2212x1661px. Acquired with a Topcon TRC-NW400. Disc-centered field
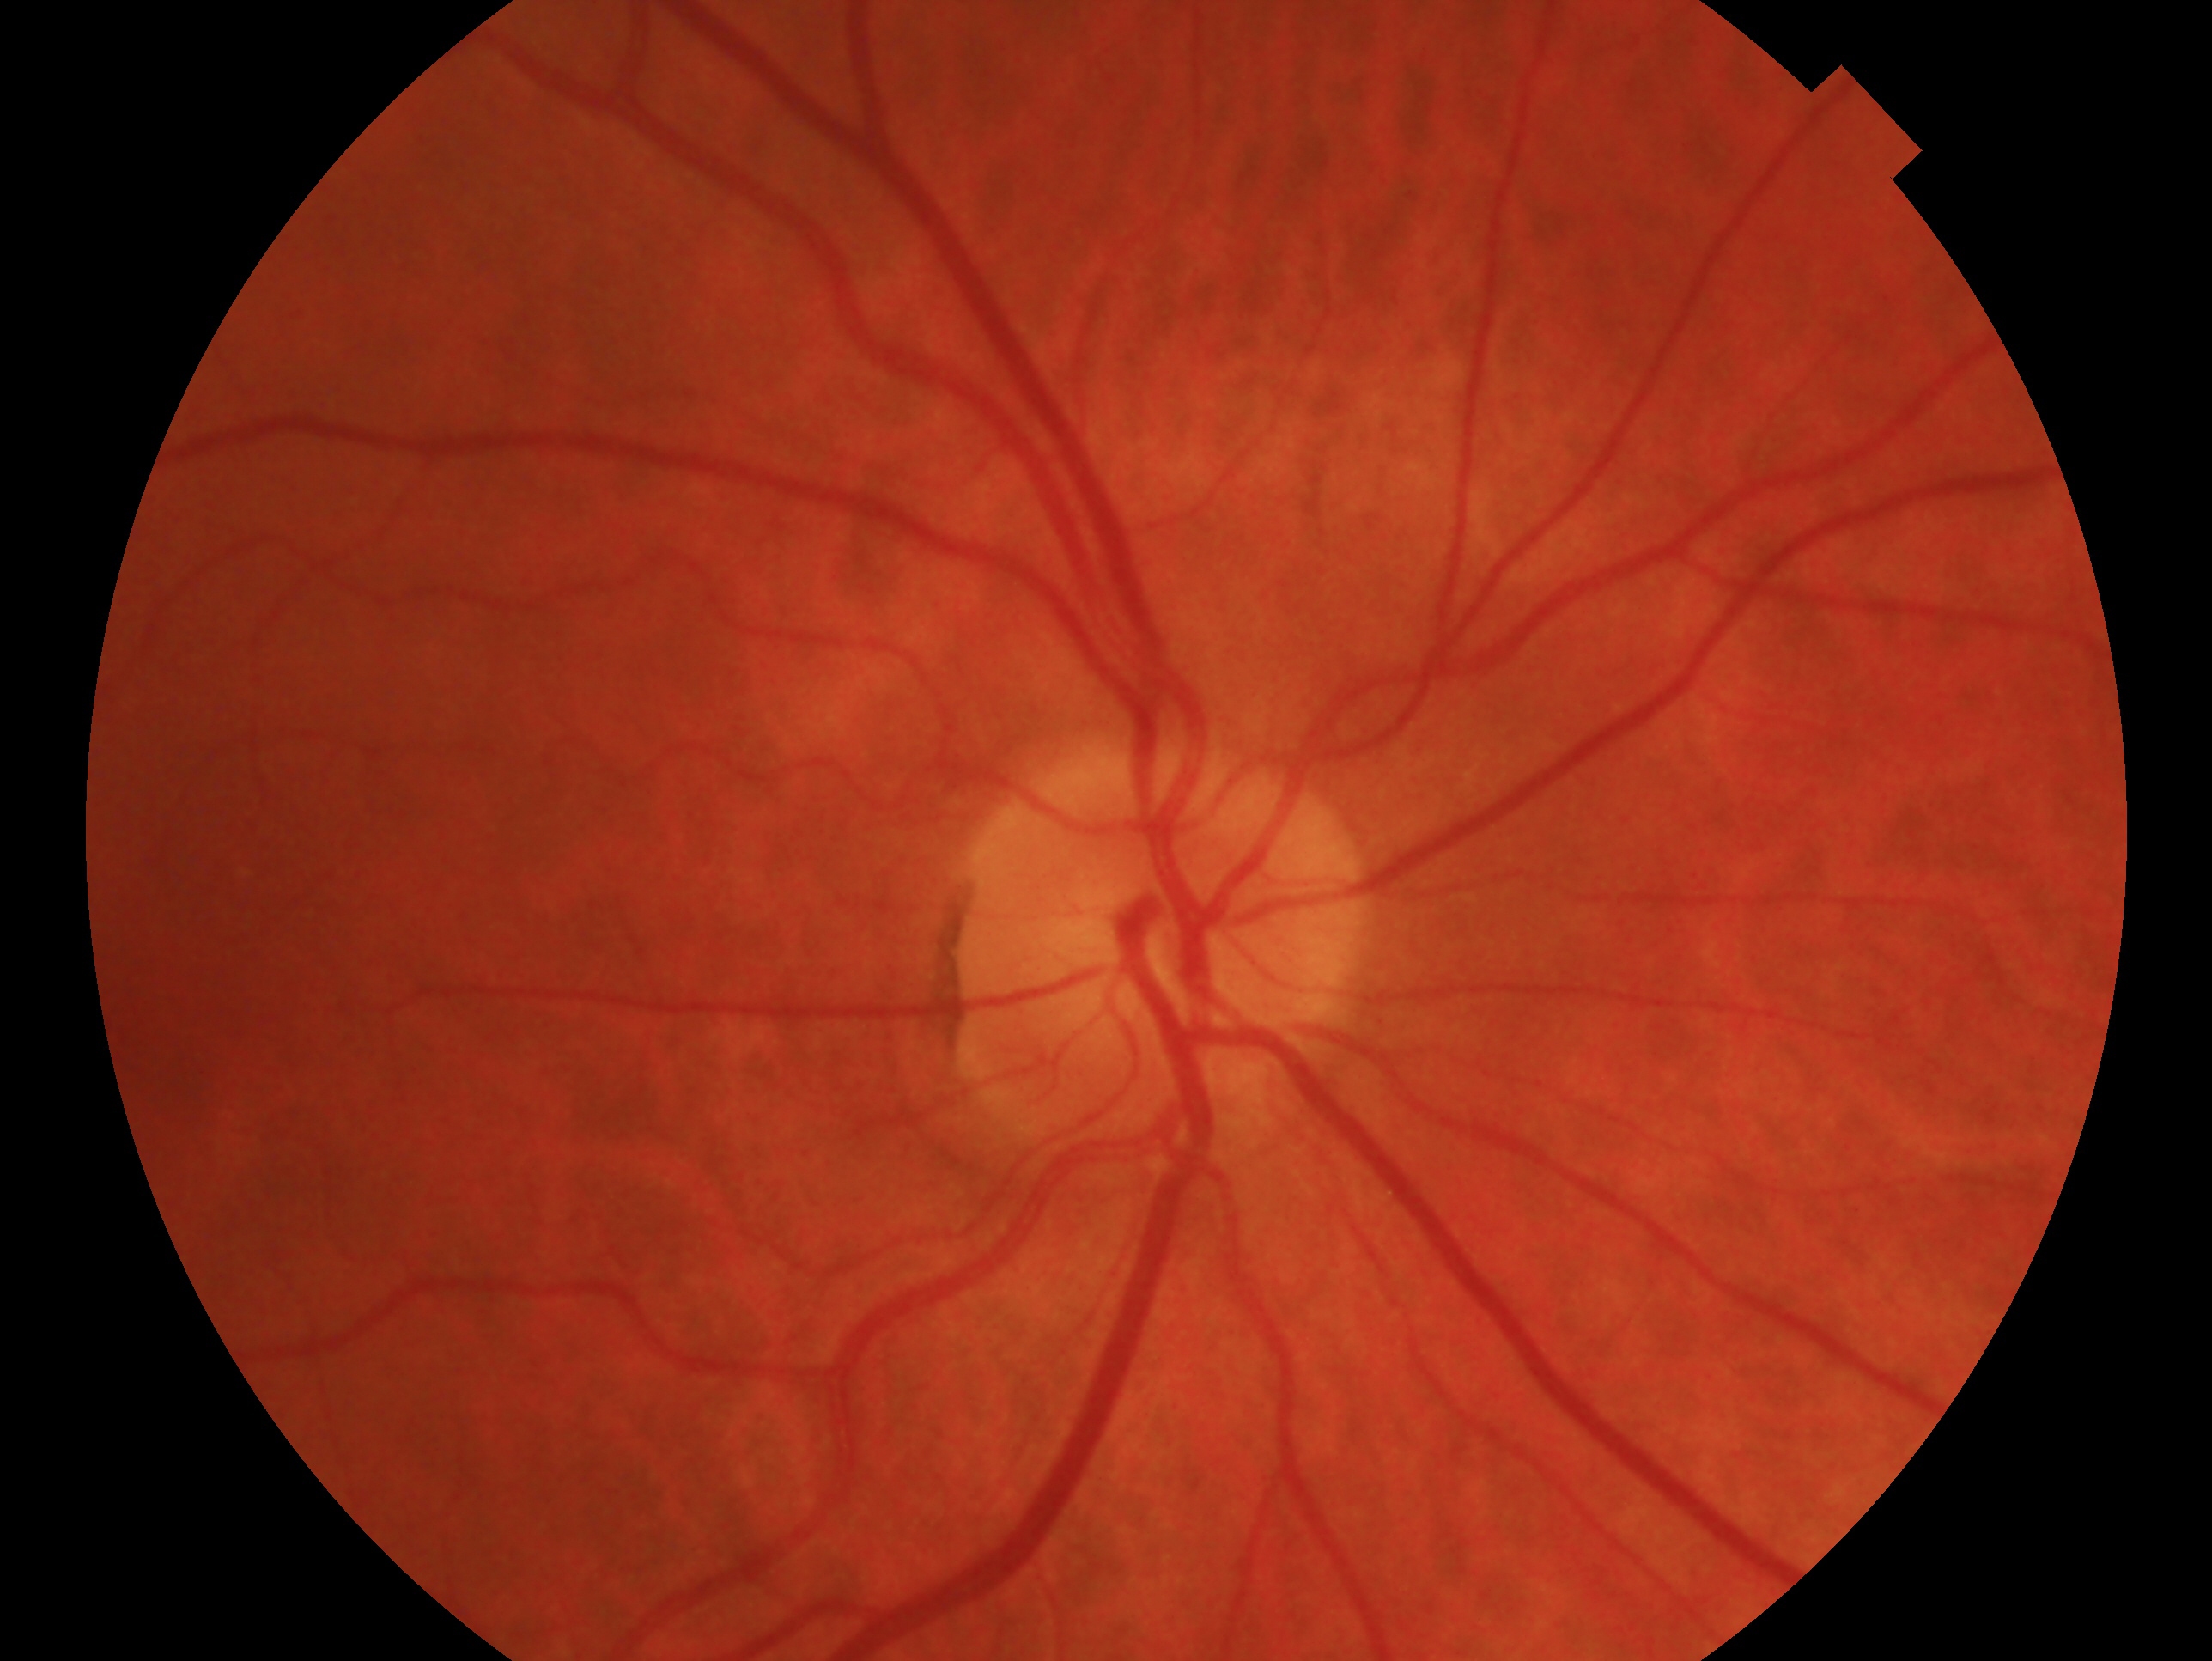 diagnosis=no glaucomatous findings | laterality=oculus dexter.